Camera: Topcon TRC-50DX; mydriatic (tropicamide and phenylephrine); FOV: 50 degrees; posterior pole field covering the optic disc and macula; CFP.
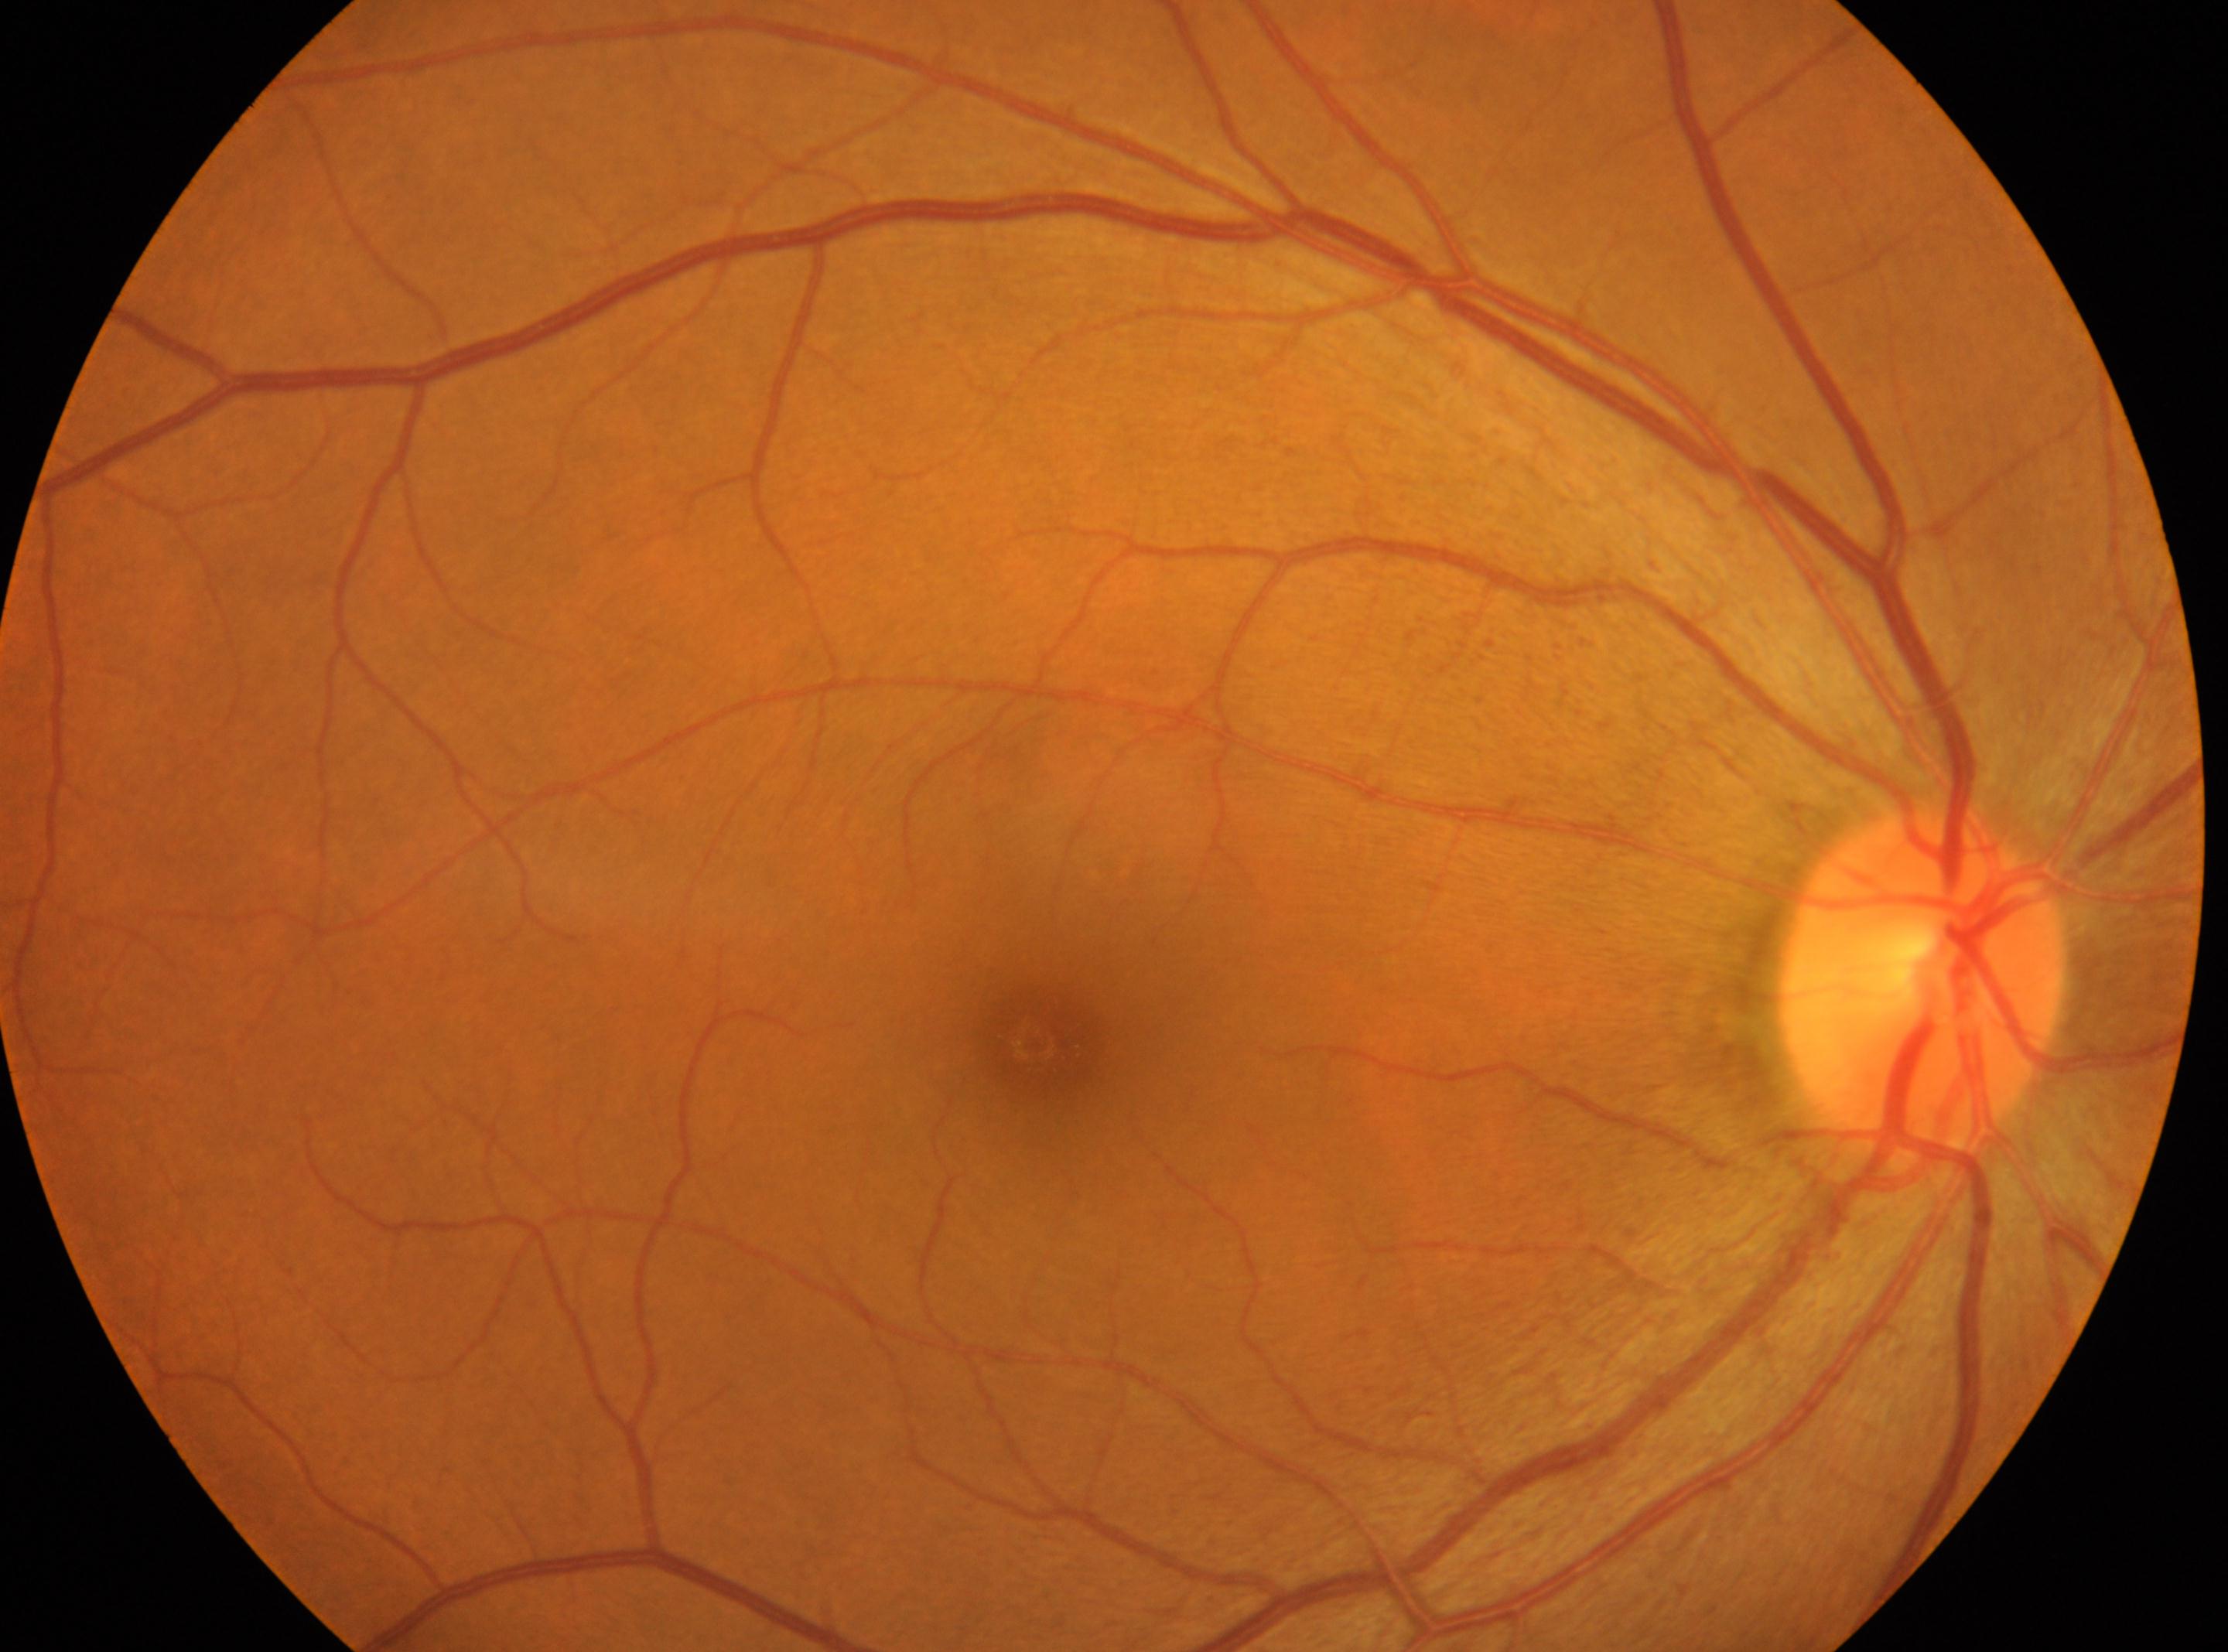 eye: oculus dexter
dr_impression: No signs of diabetic retinopathy
fovea: 1030px, 1043px
dr_grade: 0 — no visible signs of diabetic retinopathy
optic_disc: 1920px, 985px